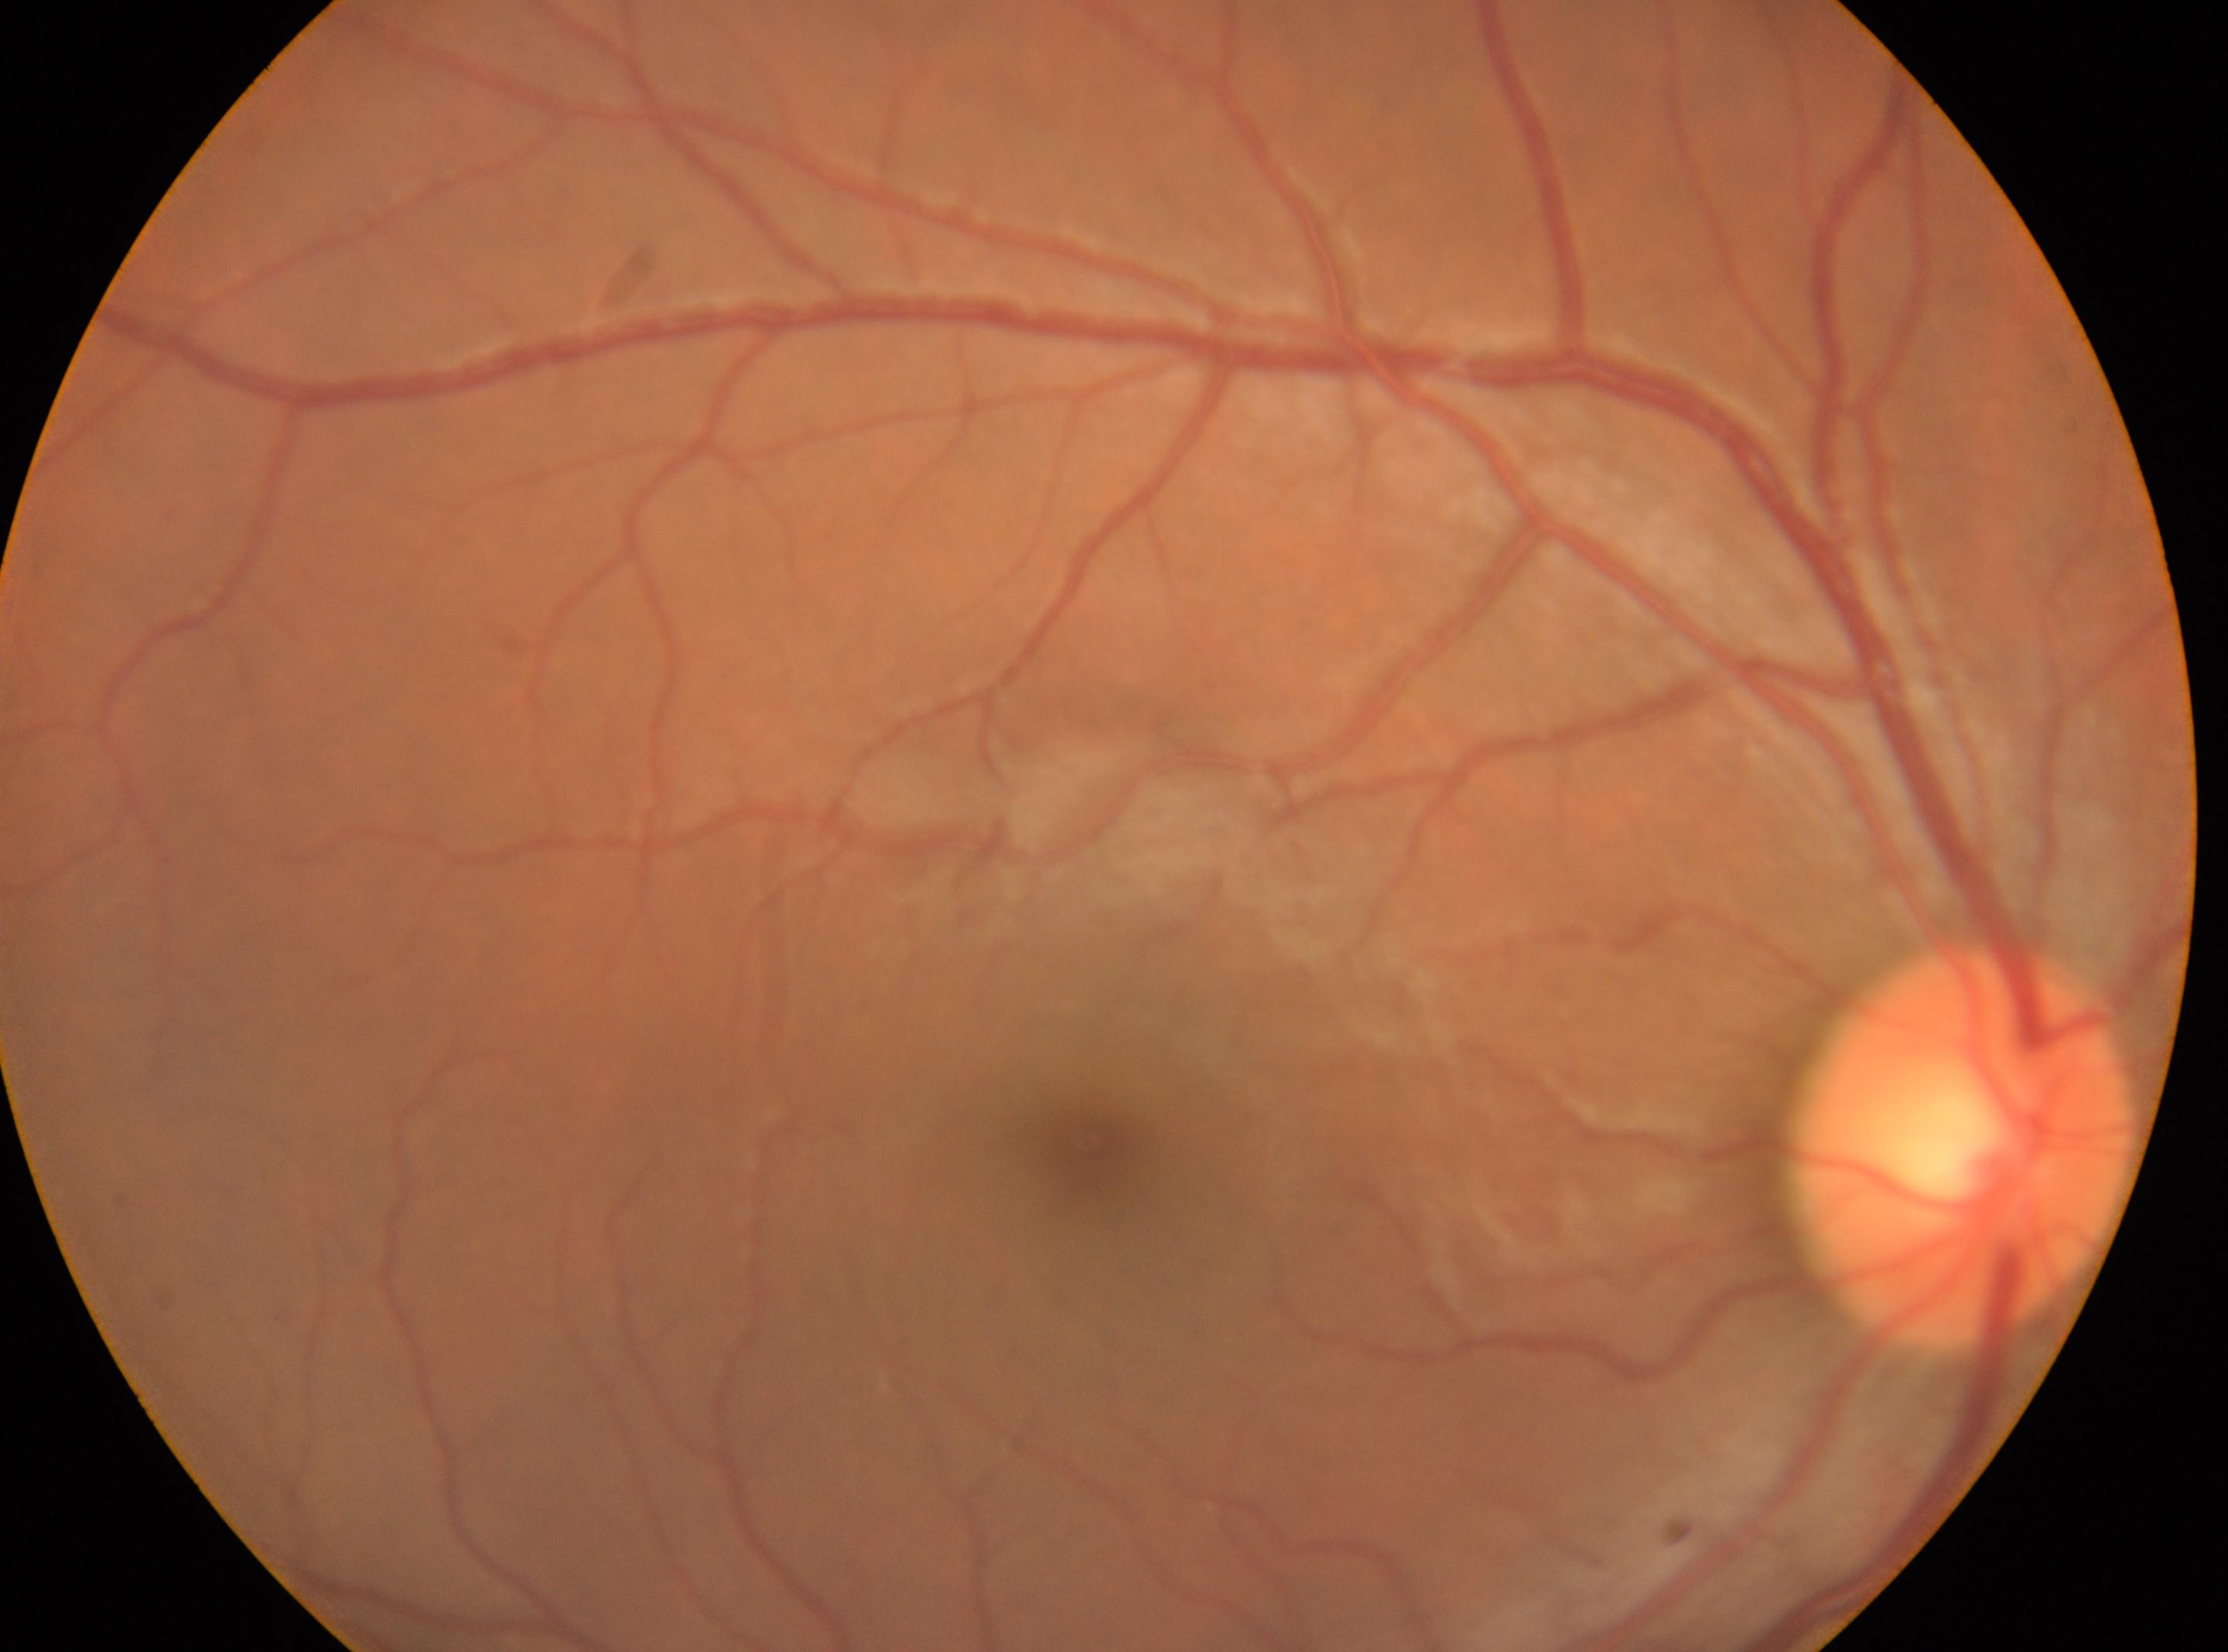

• DR impression: No diabetic retinopathy identified
• fovea centralis: 1088px, 1143px
• laterality: the right eye
• retinopathy: 0/4
• optic nerve head: 1967px, 1142px